Wide-field contact fundus photograph of an infant. Acquired on the Phoenix ICON.
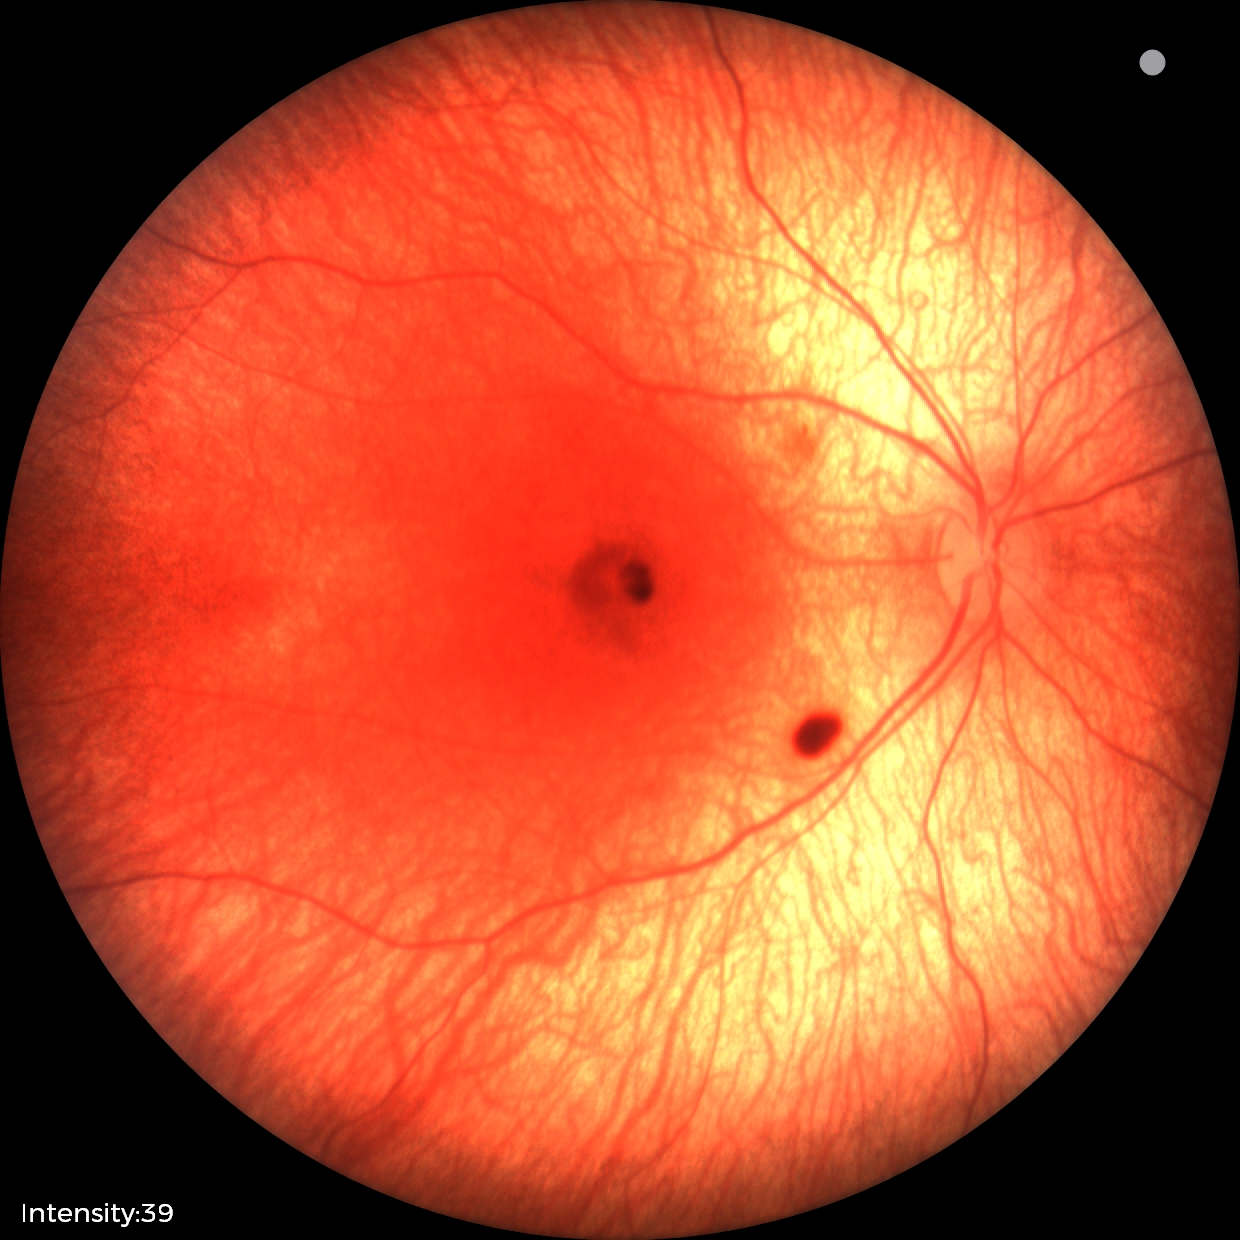 Examination diagnosed as retinal hemorrhages.